NIDEK AFC-230 fundus camera; modified Davis grading — 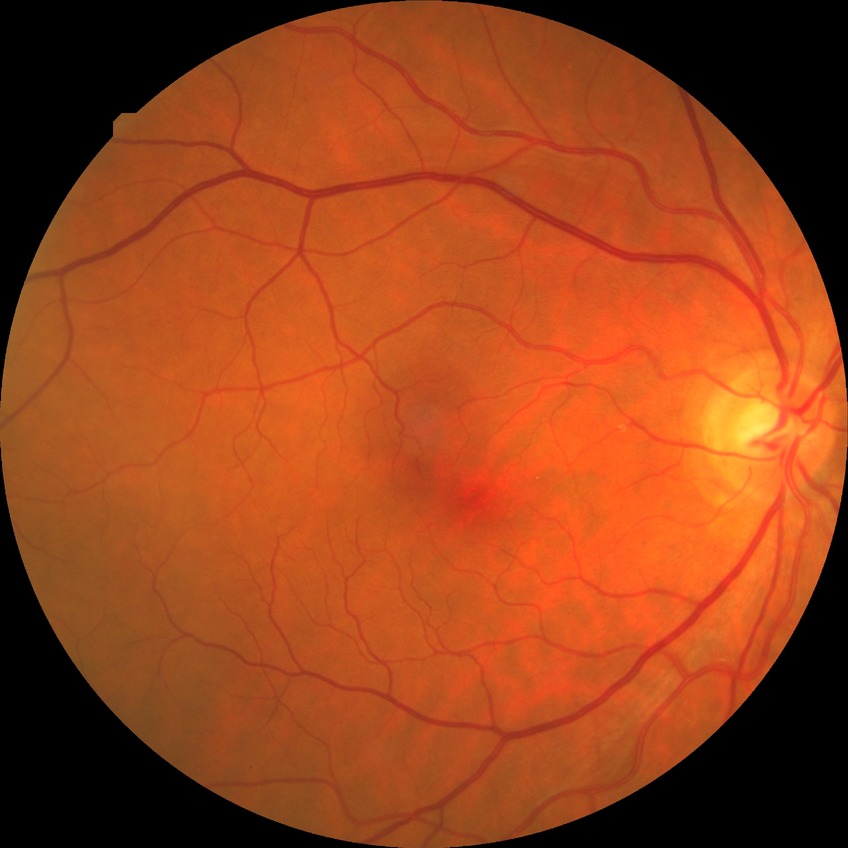 davis_grade: no diabetic retinopathy